Without pupil dilation. Graded on the modified Davis scale — 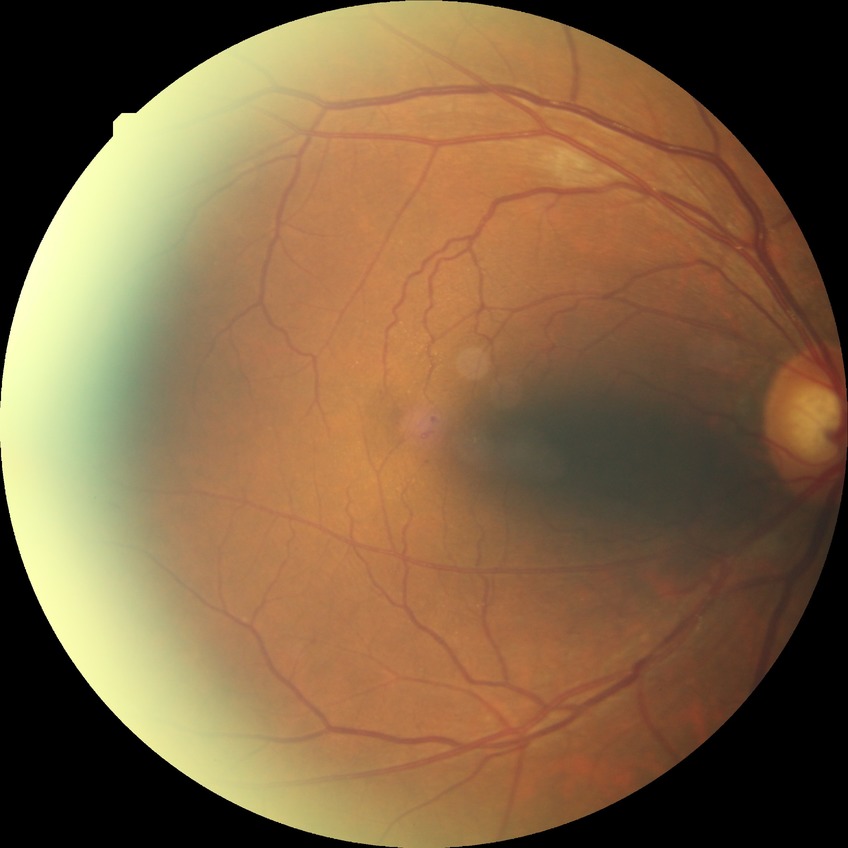
Diabetic retinopathy (DR) is no diabetic retinopathy (NDR).